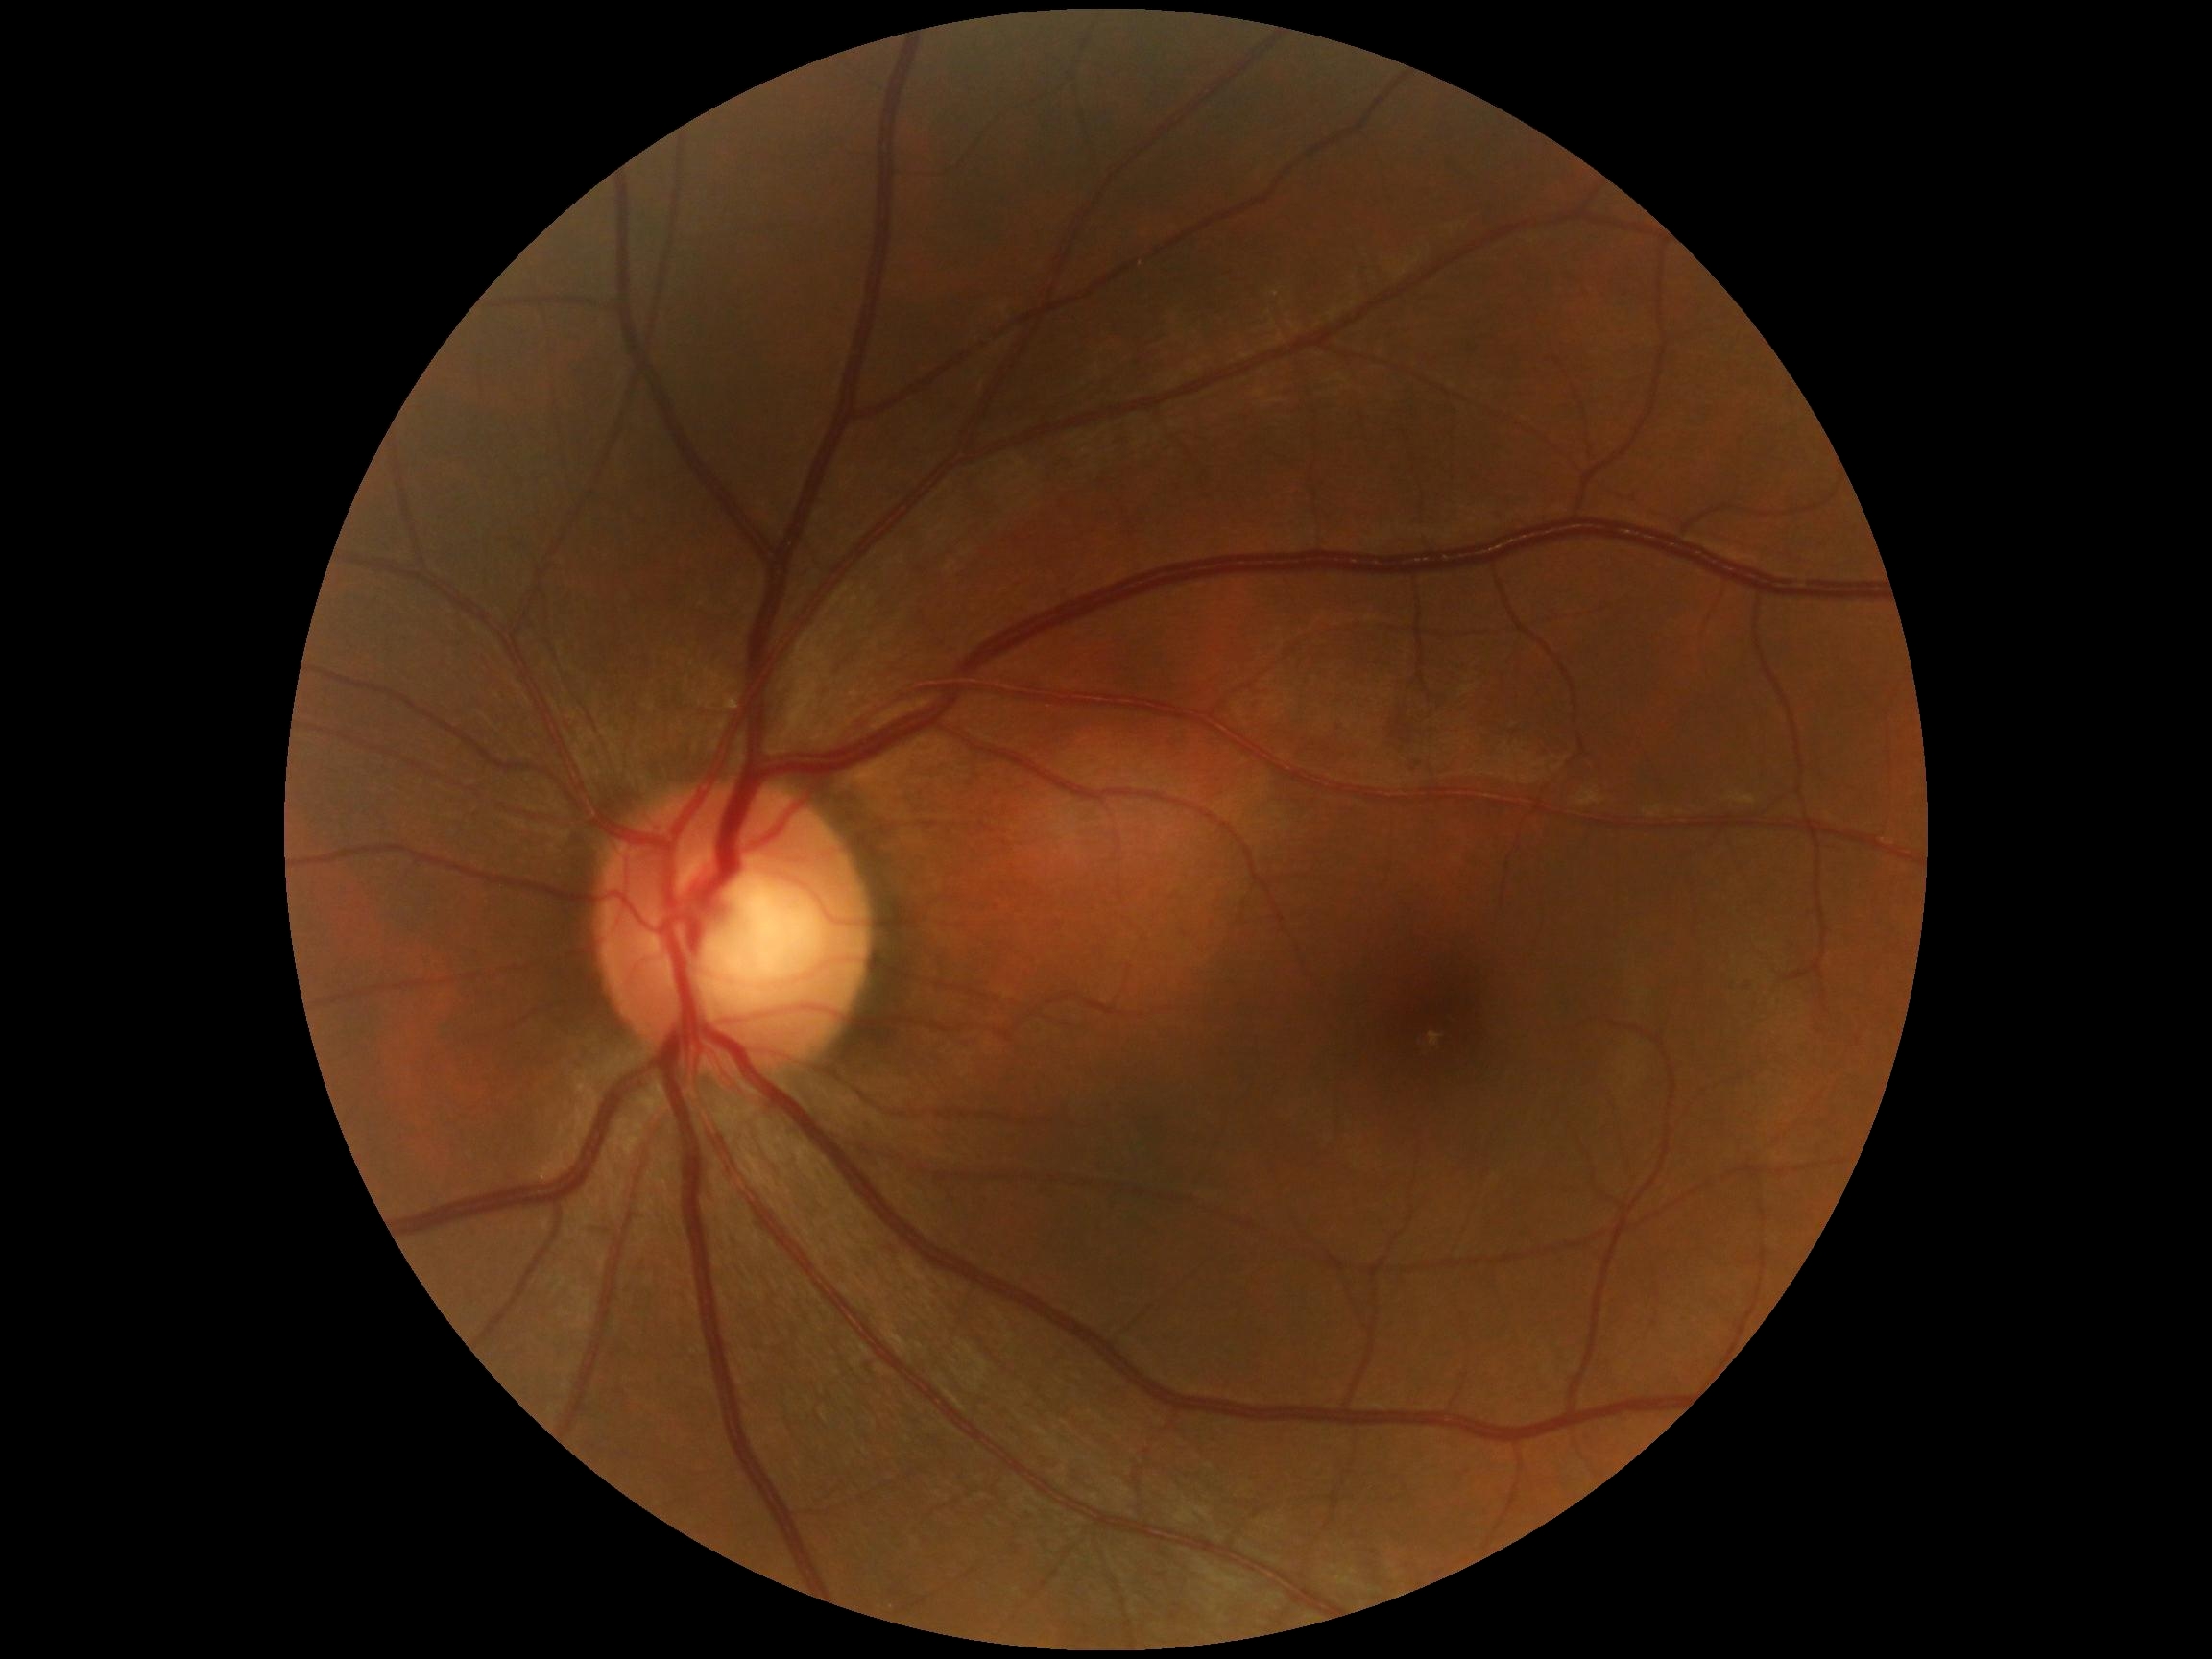
Diabetic retinopathy grade is no apparent diabetic retinopathy (0) — no visible signs of diabetic retinopathy.